Captured after pupil dilation:
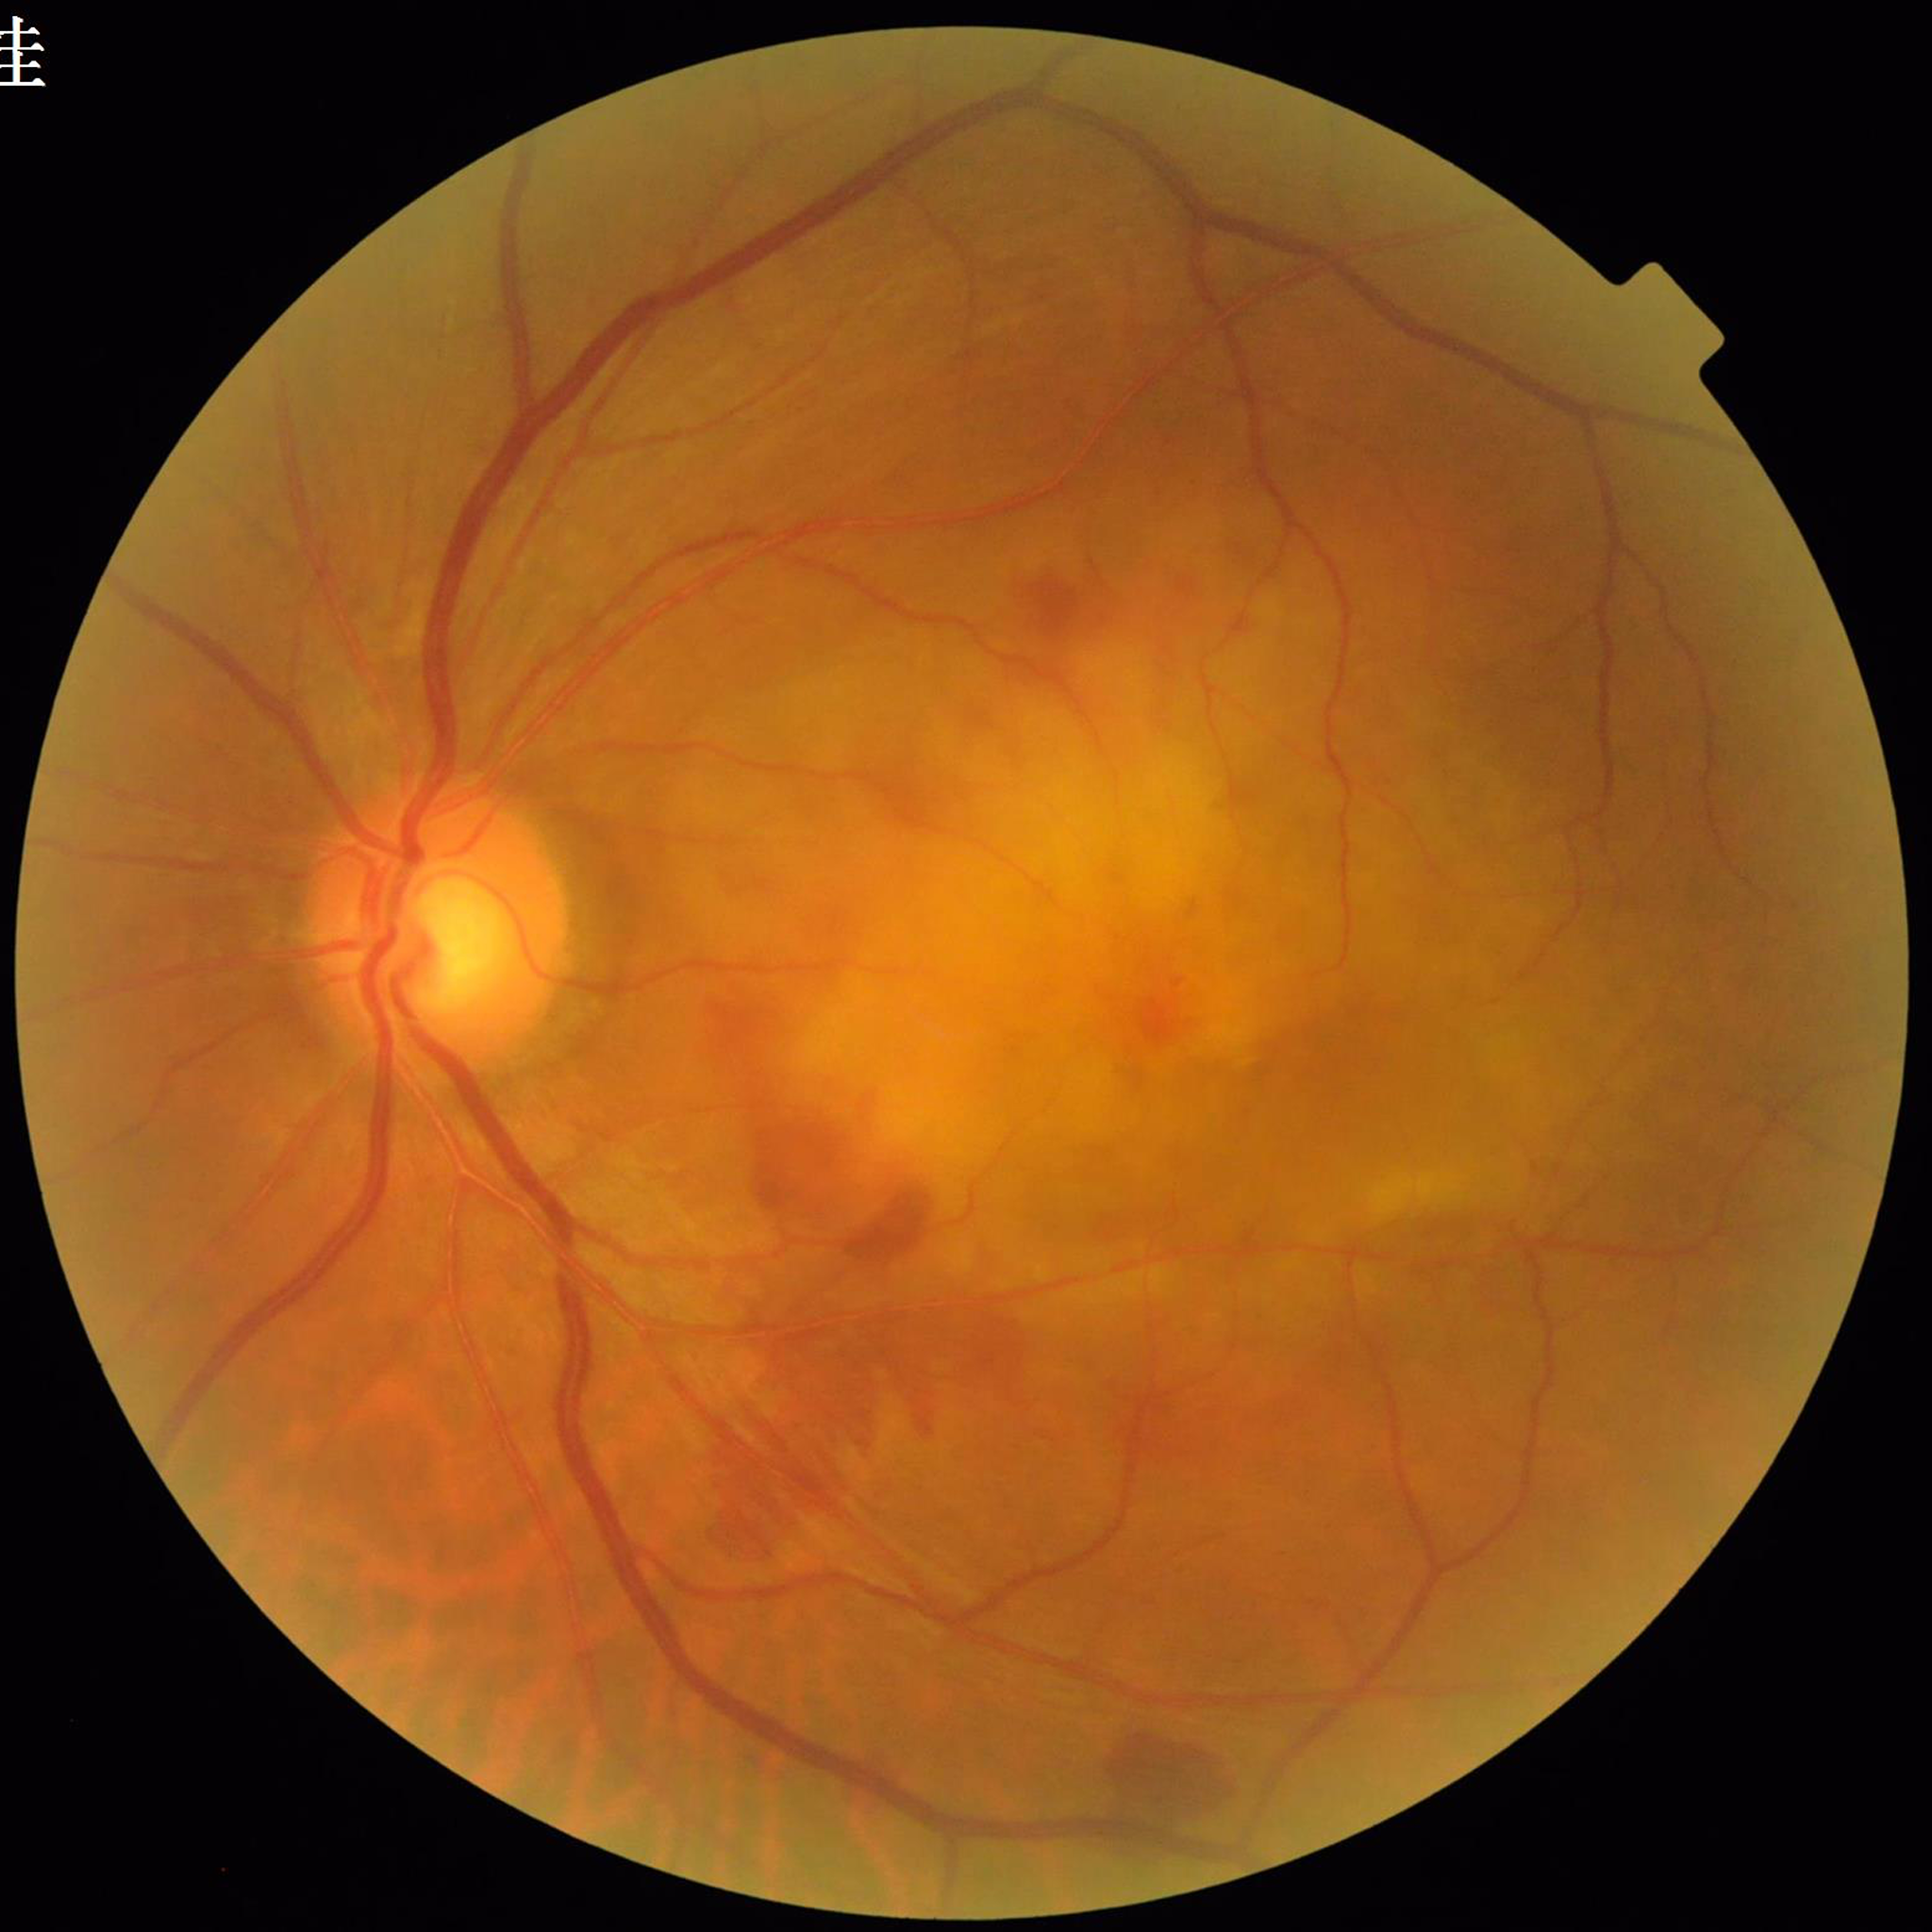 Color fundus photo. Patient diagnosed with age-related macular degeneration.